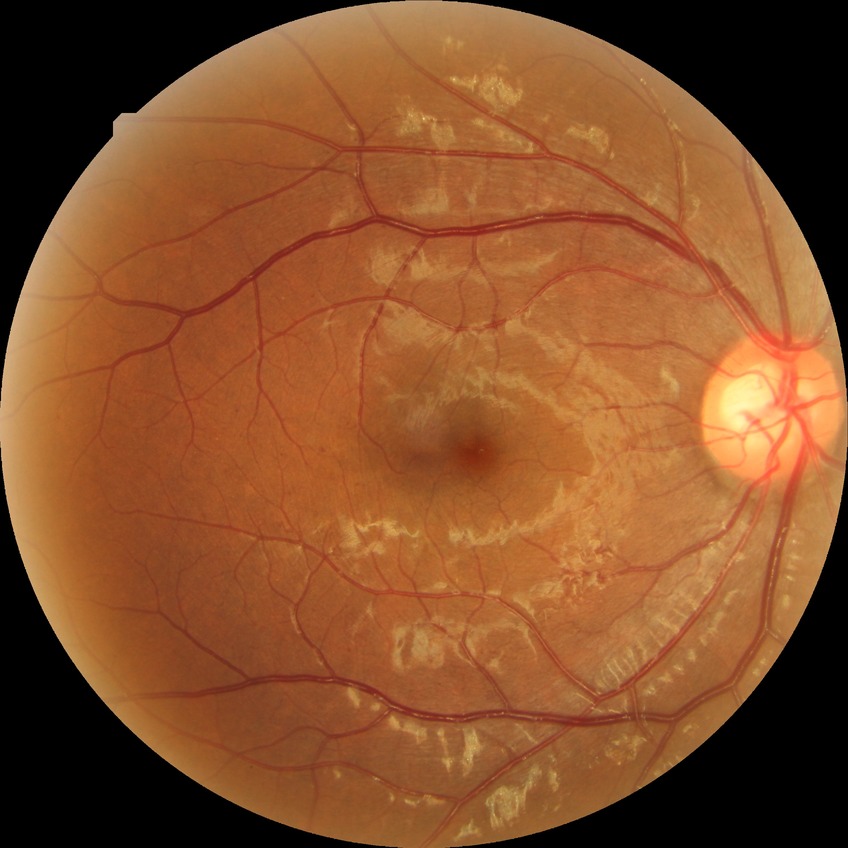

  davis_grade: SDR (simple diabetic retinopathy)